Retinal fundus photograph; image size 2352x1568
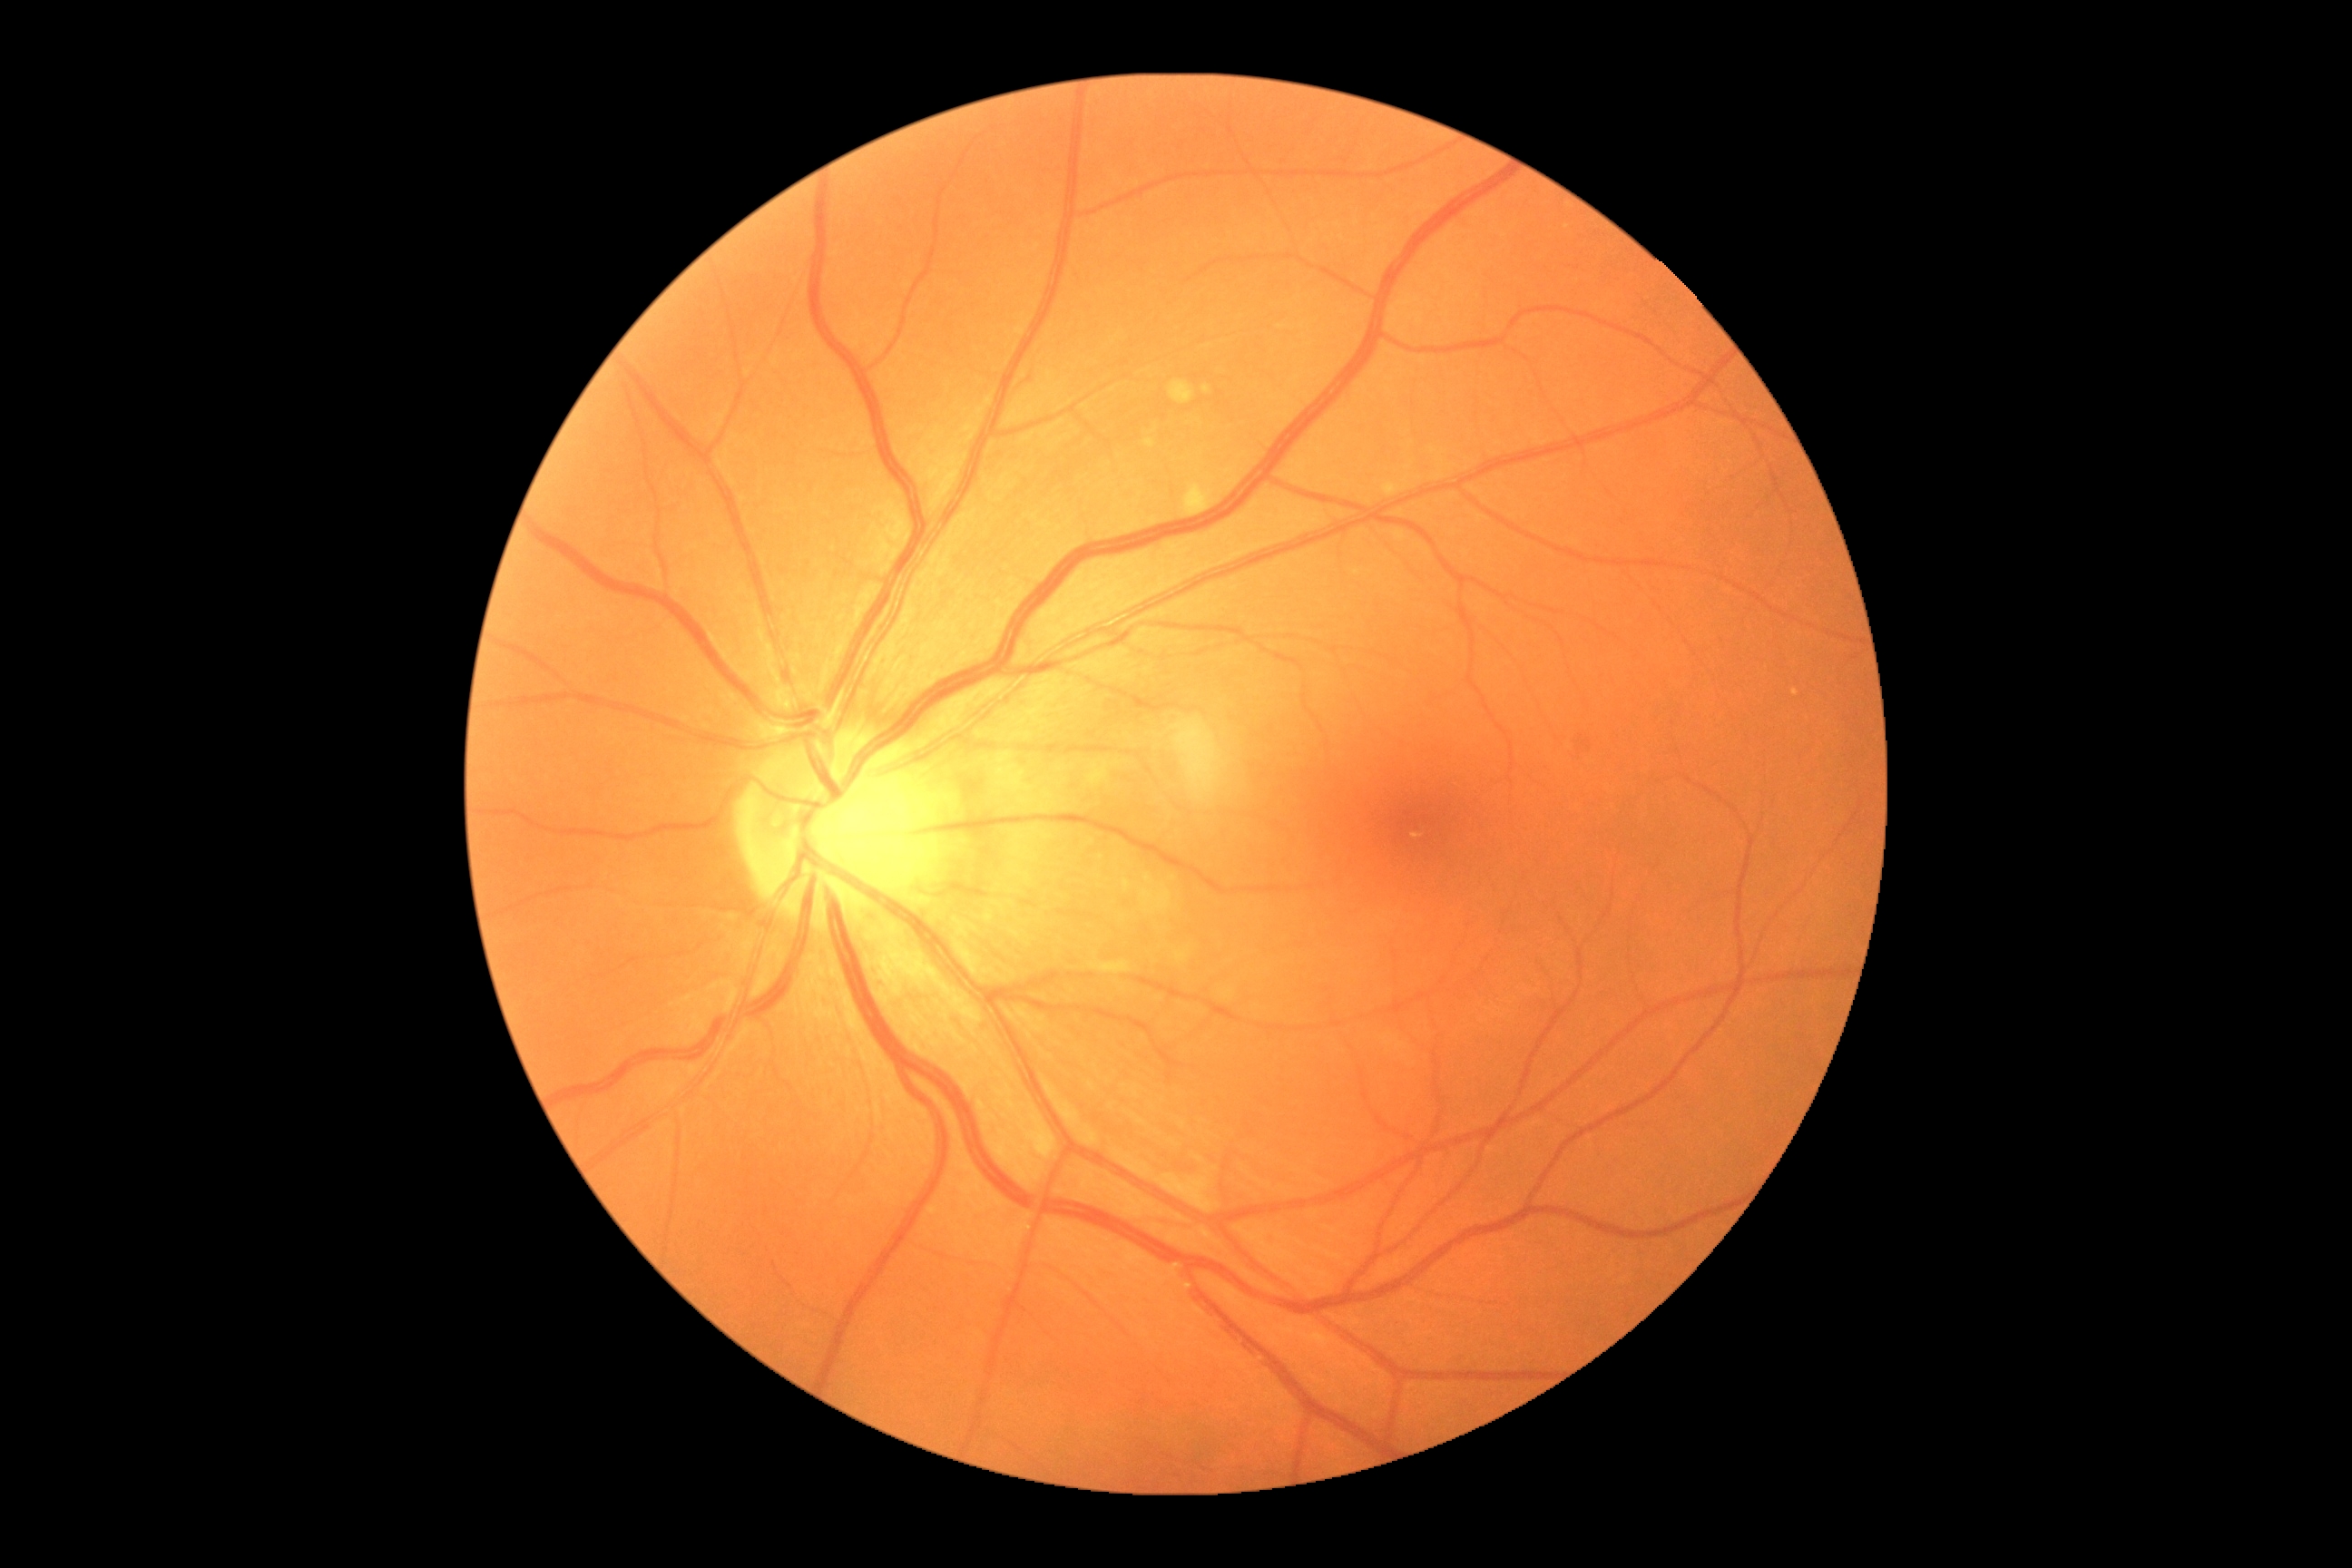 DR is 0.